Image size 240x240; centered on the optic disc
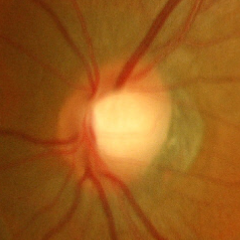

Q: Is glaucoma present?
A: No glaucoma.